Retinal fundus photograph; 2048x1536px.
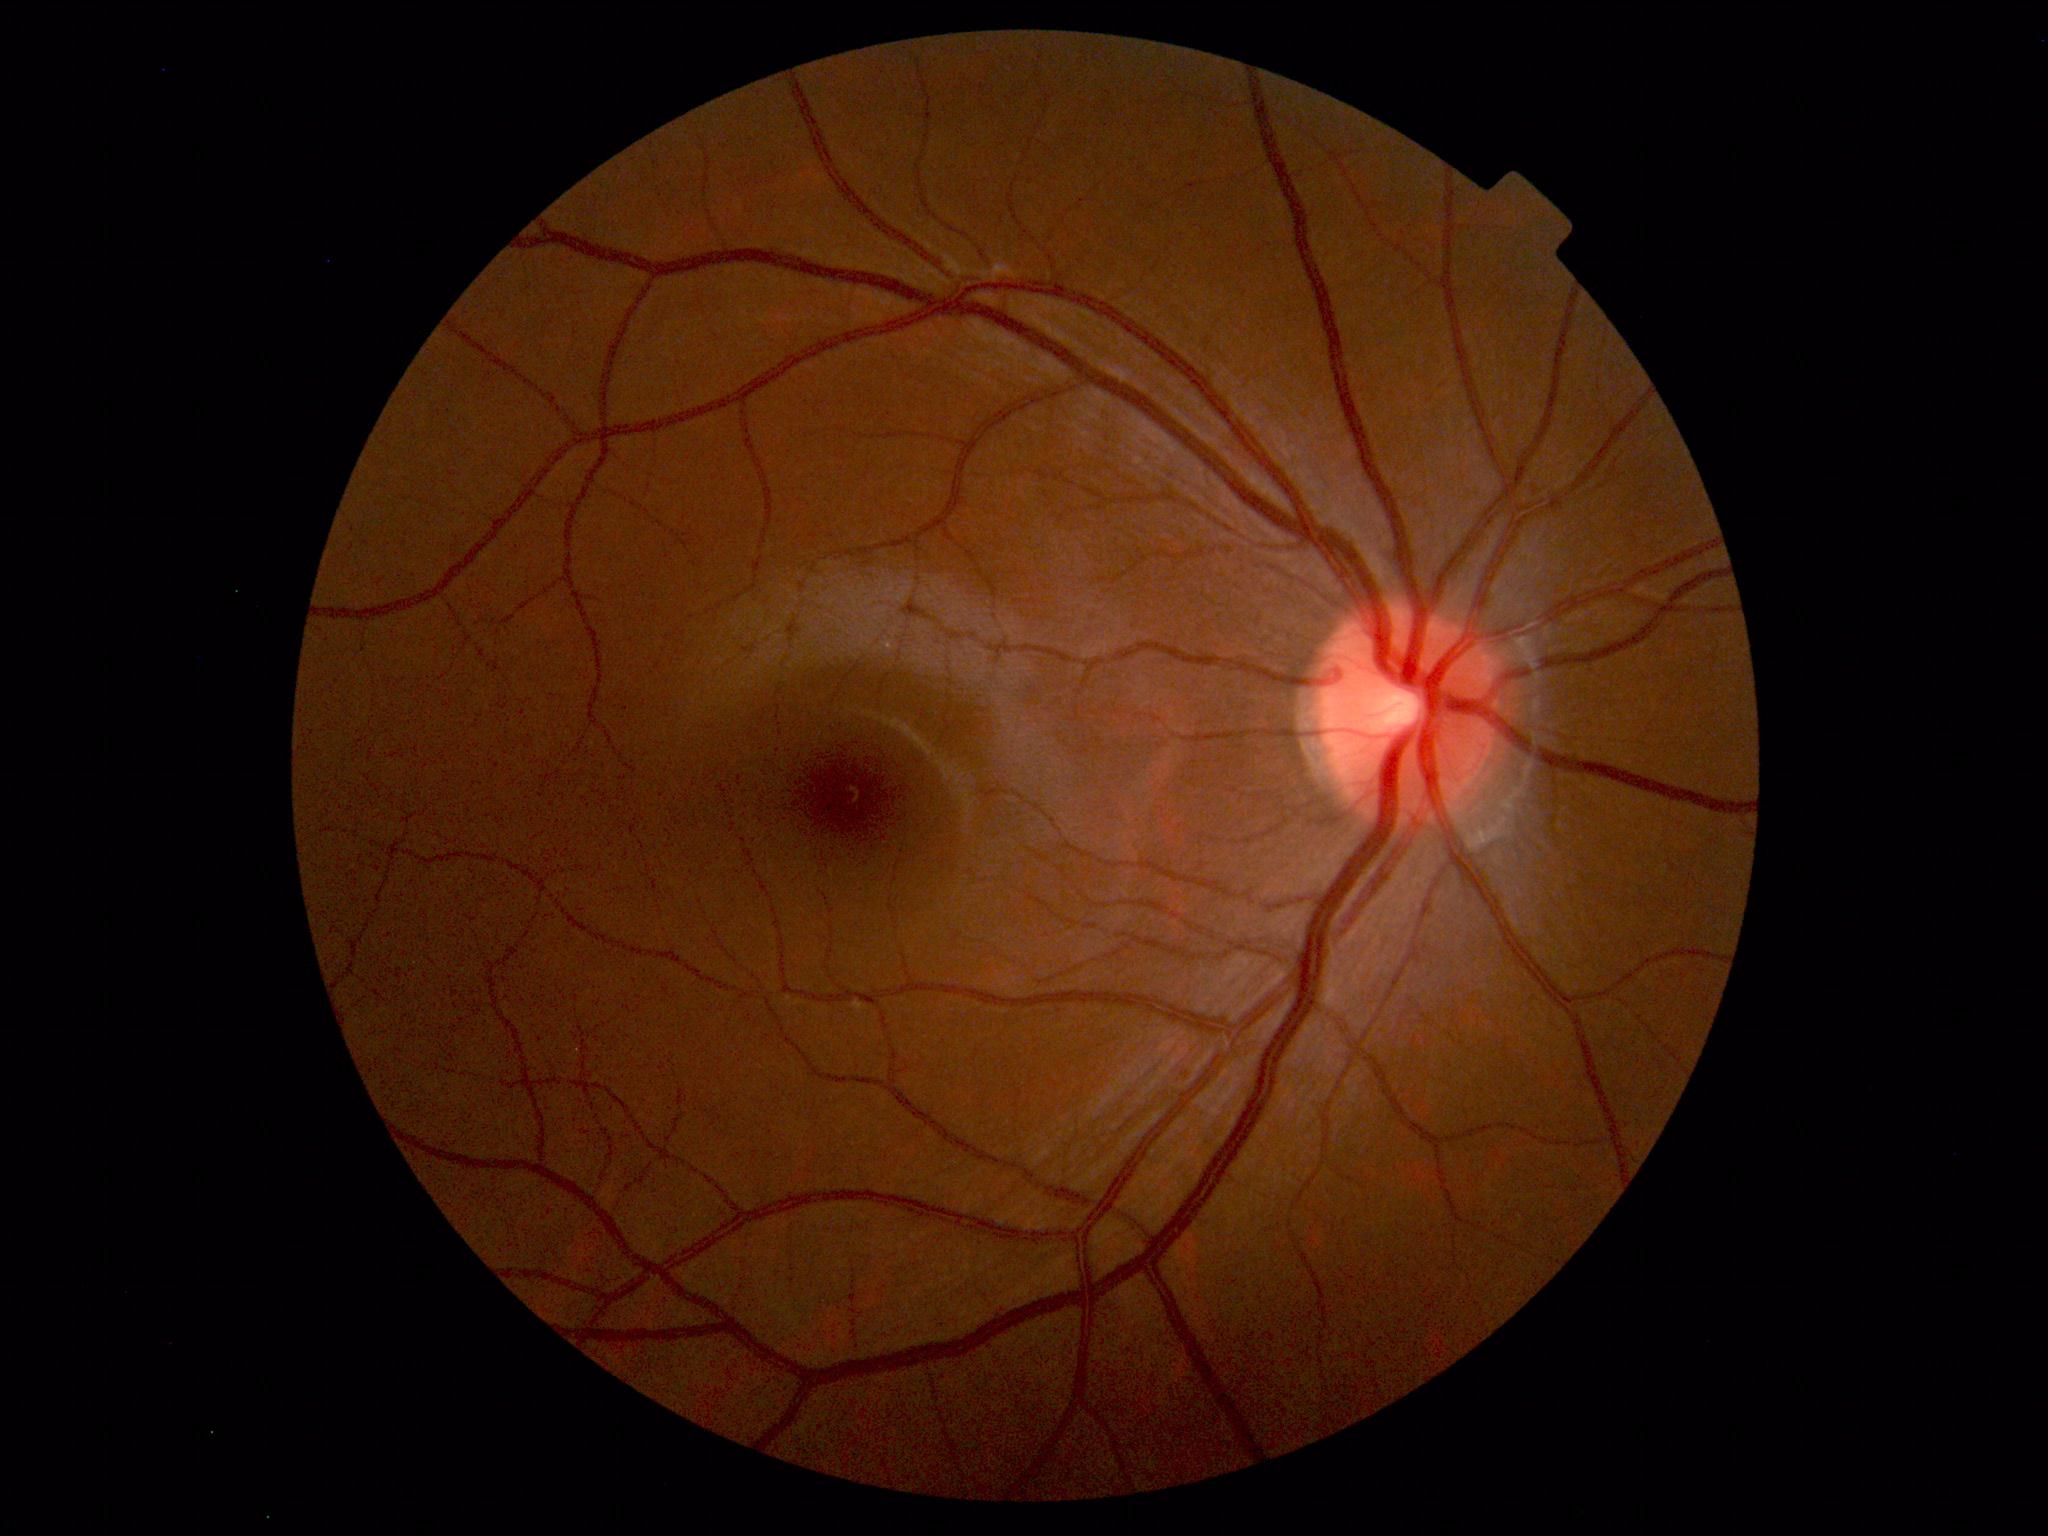

Impression: normal fundus.